Modified Davis classification:
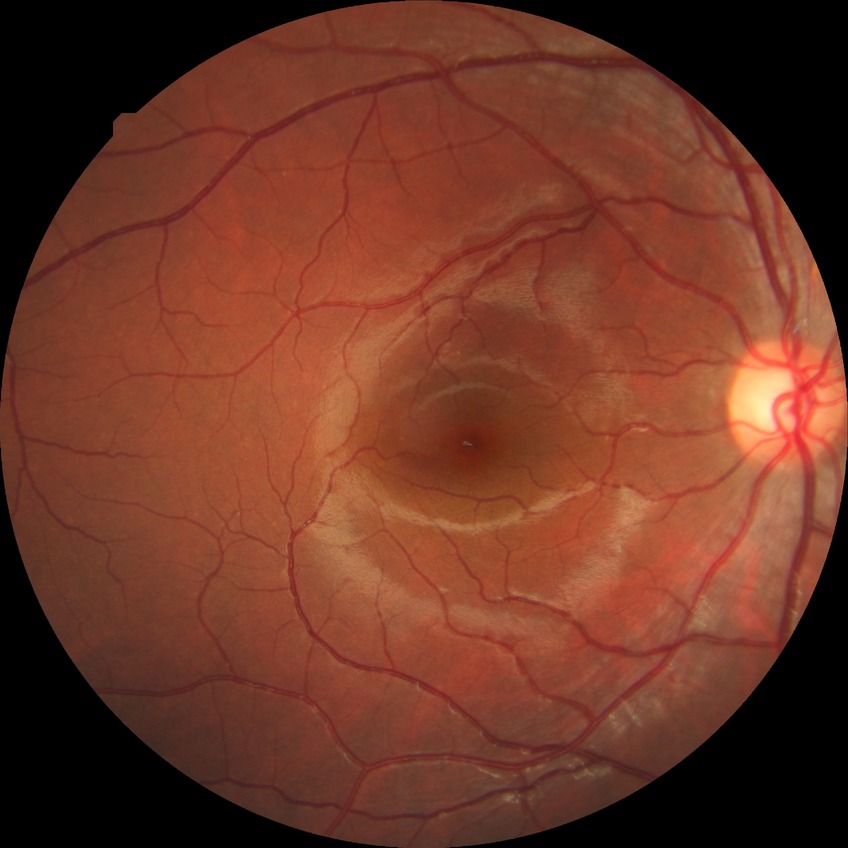 Diabetic retinopathy (DR): NDR (no diabetic retinopathy).